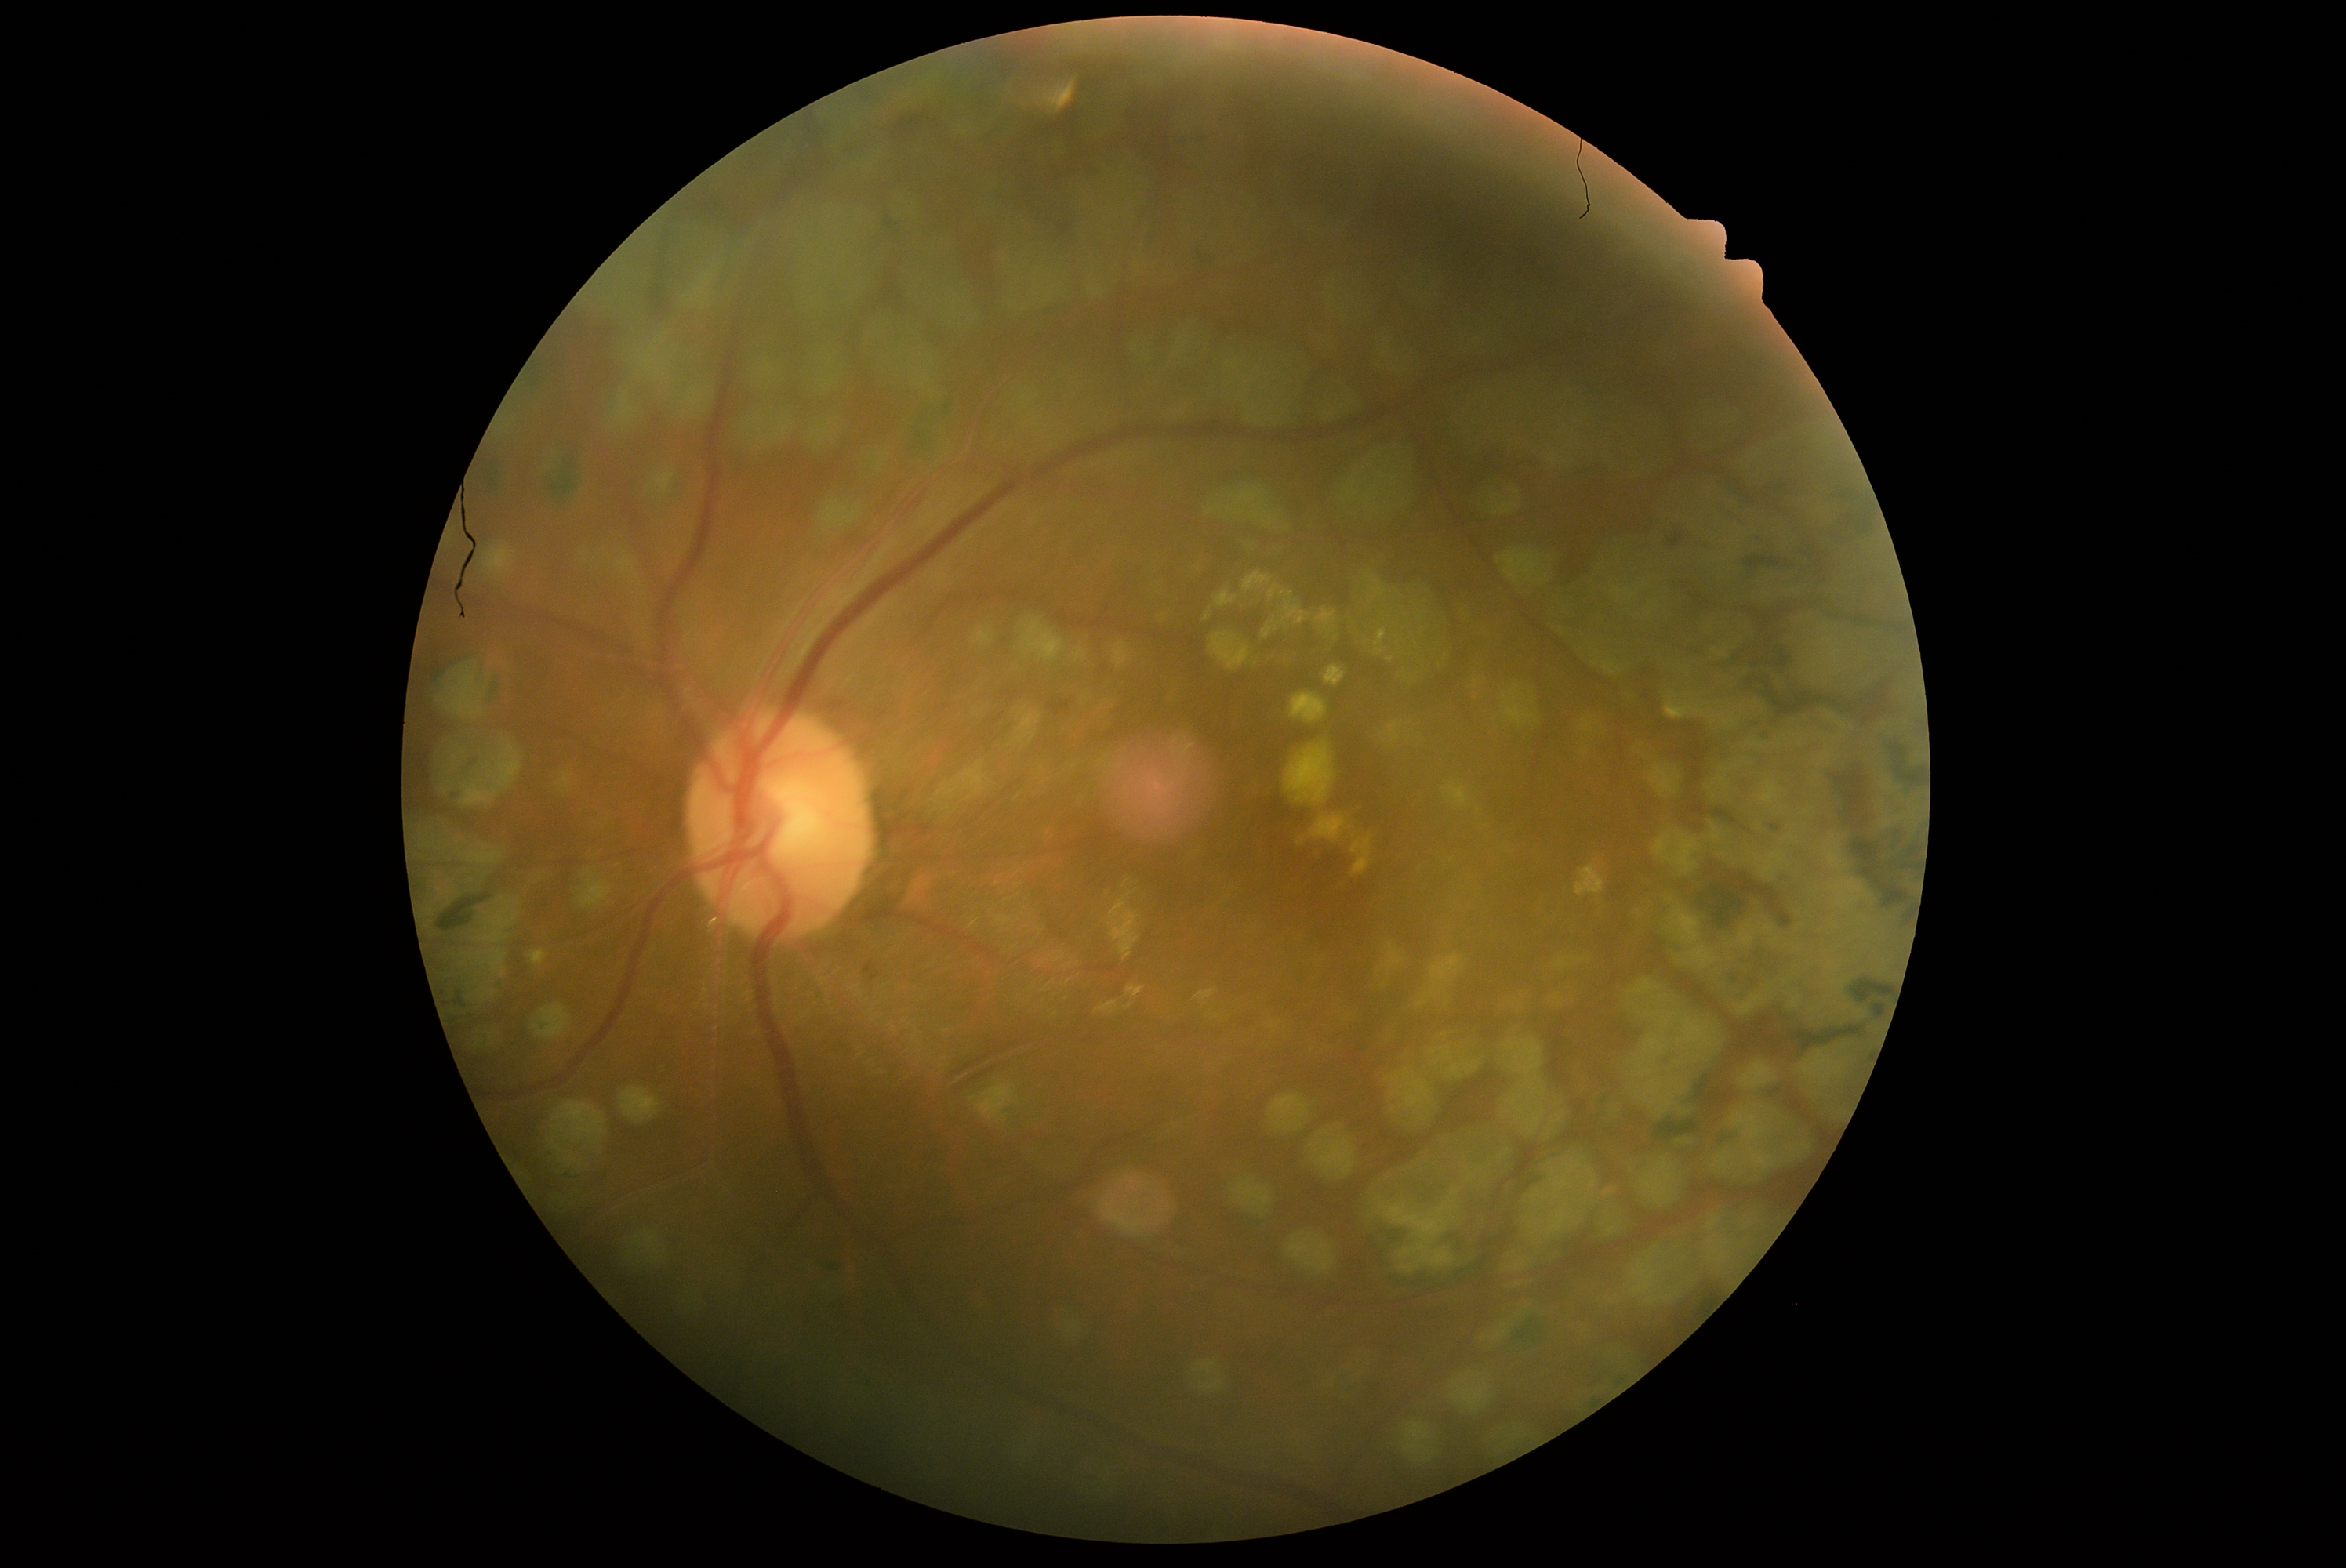 Retinopathy: grade 2.
Disease class: non-proliferative diabetic retinopathy.